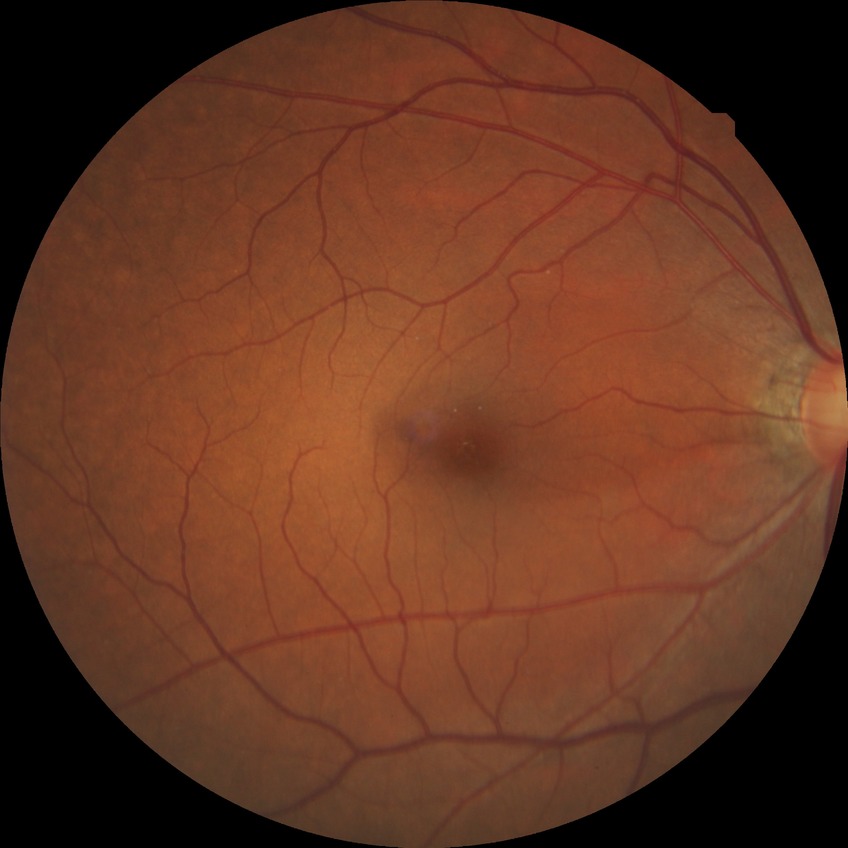

diabetic retinopathy (DR) = no diabetic retinopathy (NDR)